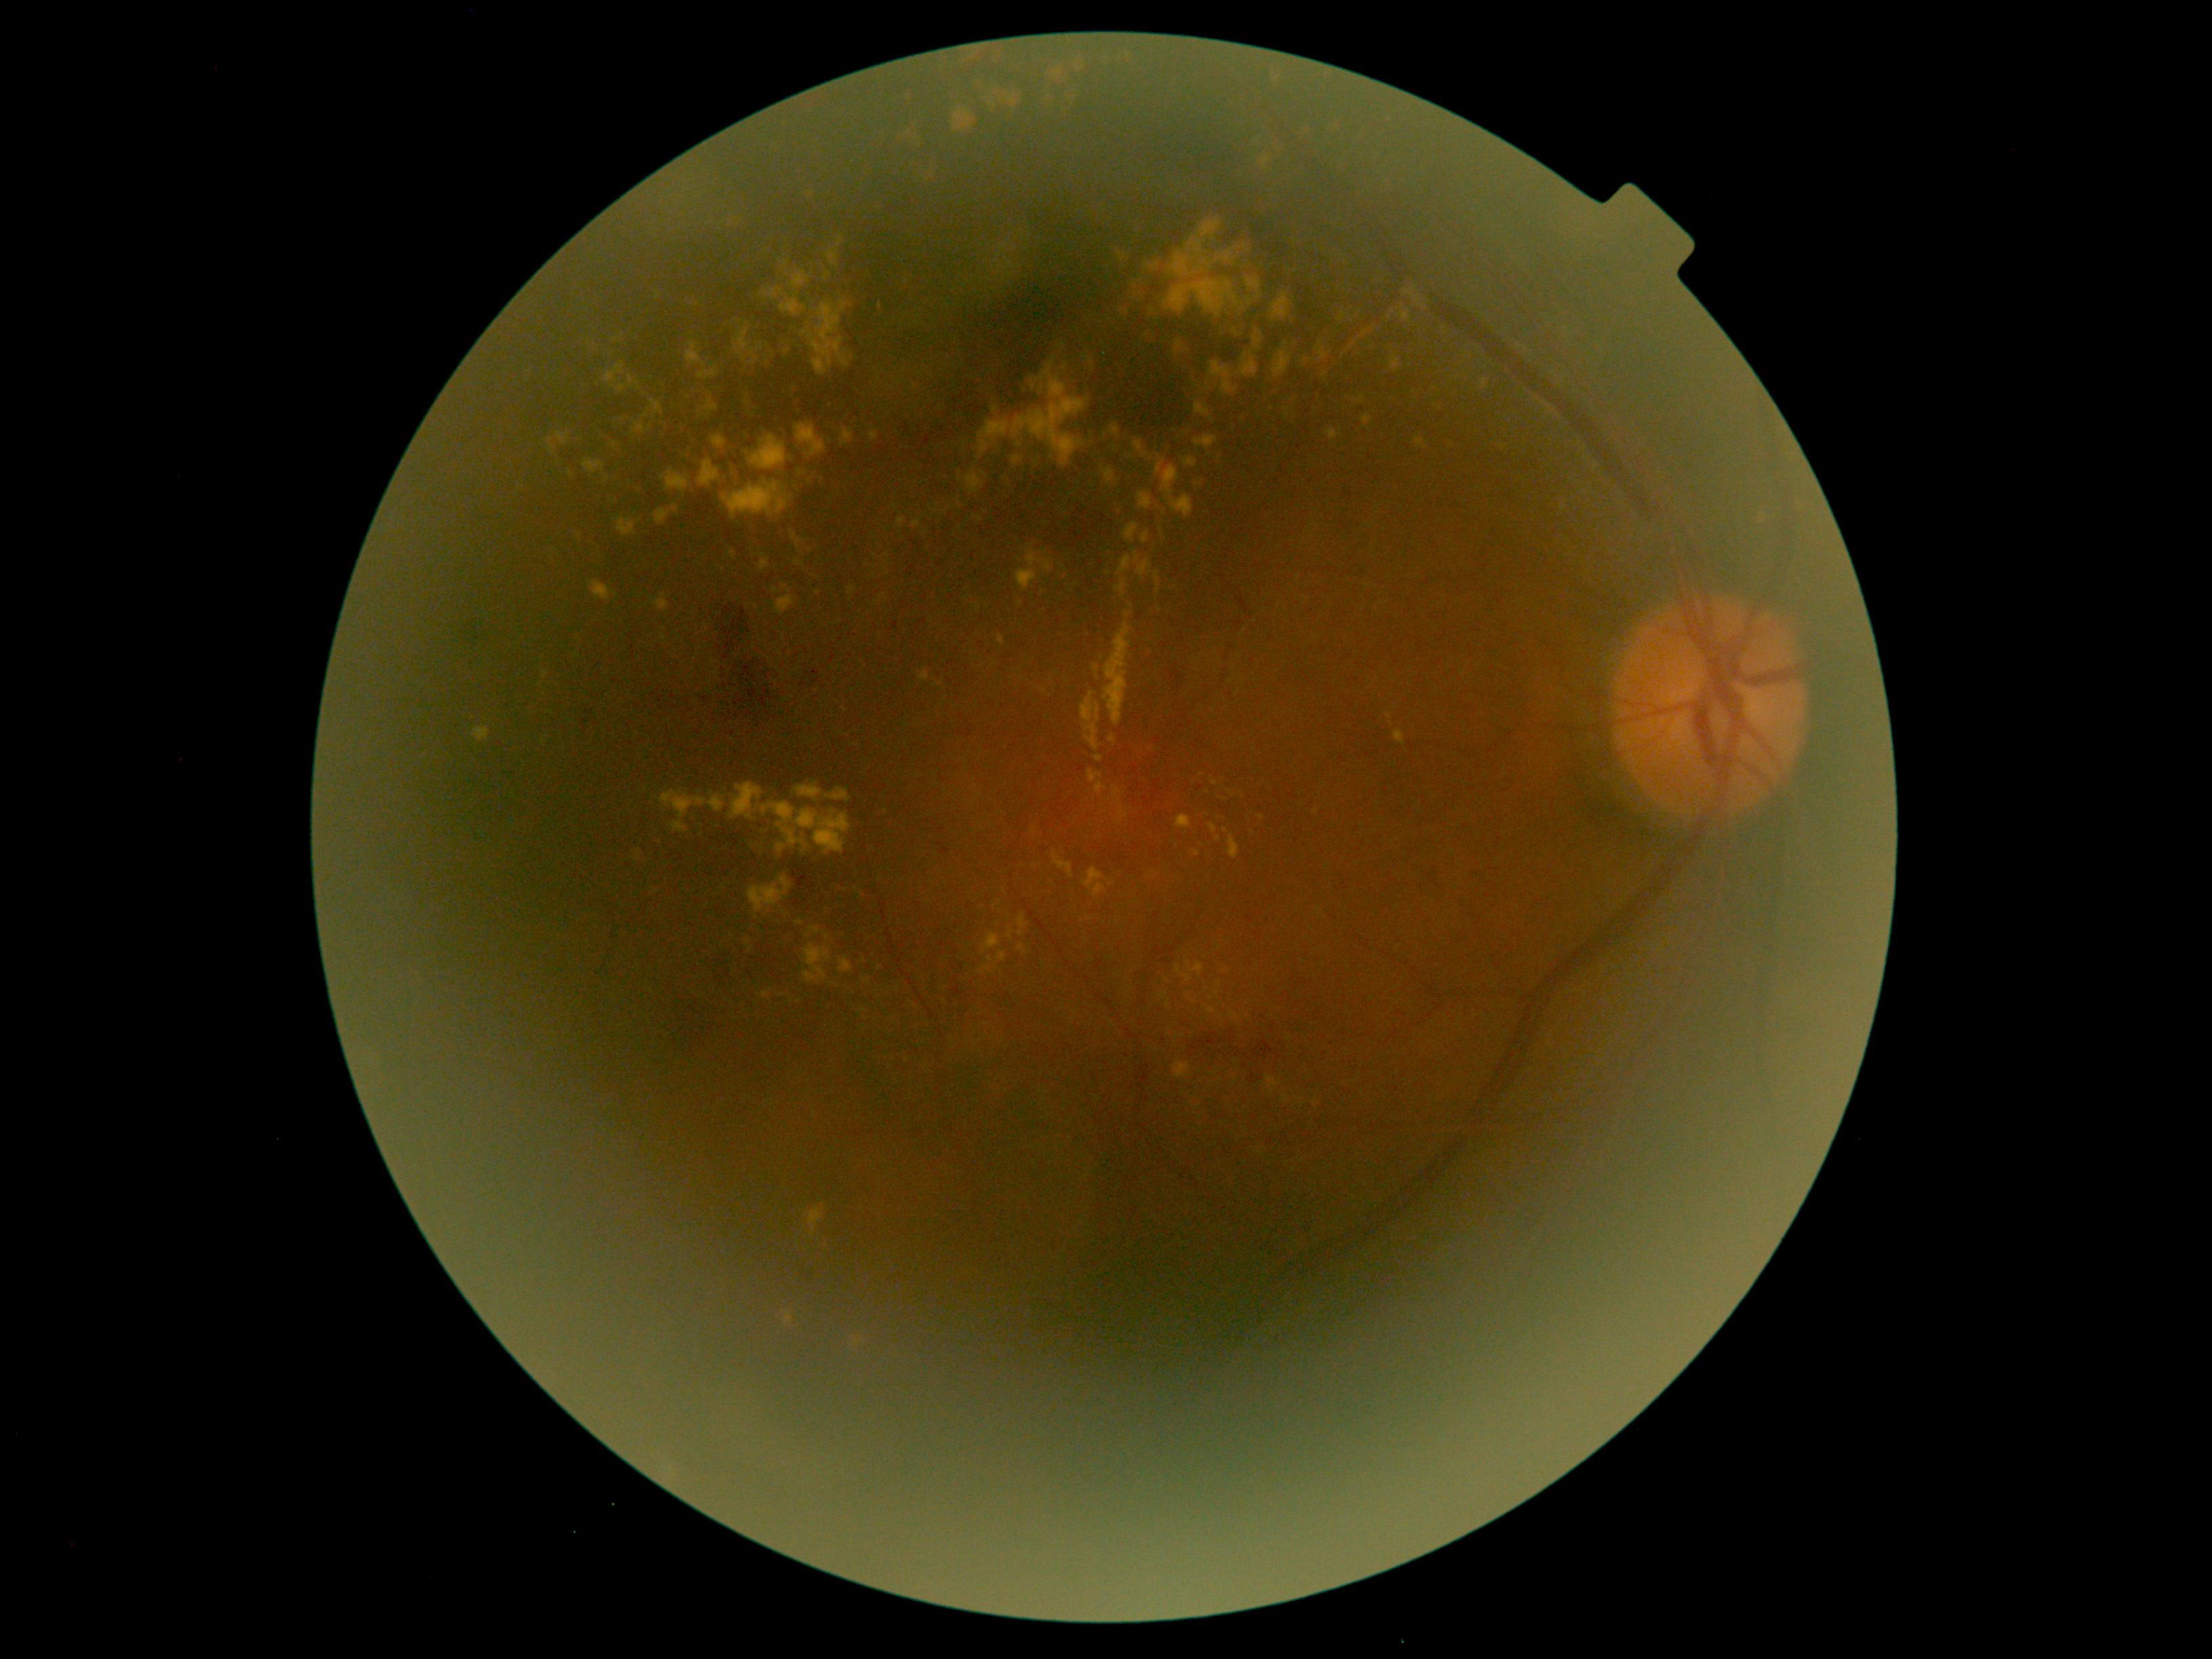
Diabetic retinopathy (DR): grade 2 (moderate NPDR)
Representative lesions:
hard exudates (EXs) (continued): {"left": 827, "top": 235, "right": 842, "bottom": 266}, {"left": 1113, "top": 787, "right": 1124, "bottom": 798}, {"left": 1109, "top": 425, "right": 1120, "bottom": 438}, {"left": 1248, "top": 298, "right": 1253, "bottom": 306}, {"left": 1017, "top": 550, "right": 1054, "bottom": 593}, {"left": 1204, "top": 1006, "right": 1215, "bottom": 1013}, {"left": 859, "top": 45, "right": 1138, "bottom": 213}, {"left": 1245, "top": 277, "right": 1261, "bottom": 293}, {"left": 1329, "top": 120, "right": 1347, "bottom": 140}, {"left": 699, "top": 459, "right": 720, "bottom": 487}, {"left": 1267, "top": 1076, "right": 1277, "bottom": 1094}, {"left": 1126, "top": 612, "right": 1134, "bottom": 619}, {"left": 1085, "top": 357, "right": 1094, "bottom": 367}
Smaller EXs around (x=782, y=995), (x=835, y=984), (x=999, y=904), (x=1152, y=309), (x=883, y=596), (x=937, y=685), (x=1164, y=511)
hemorrhages (HEs) (continued): {"left": 1343, "top": 489, "right": 1353, "bottom": 502}, {"left": 705, "top": 954, "right": 747, "bottom": 996}, {"left": 1253, "top": 1038, "right": 1282, "bottom": 1061}, {"left": 692, "top": 688, "right": 715, "bottom": 712}, {"left": 1188, "top": 1029, "right": 1237, "bottom": 1058}, {"left": 1202, "top": 1052, "right": 1210, "bottom": 1062}, {"left": 1248, "top": 1071, "right": 1265, "bottom": 1084}, {"left": 802, "top": 670, "right": 829, "bottom": 697}, {"left": 719, "top": 604, "right": 779, "bottom": 724}, {"left": 914, "top": 1130, "right": 924, "bottom": 1139}, {"left": 853, "top": 250, "right": 1115, "bottom": 463}
microaneurysms (MAs): none detected
soft exudates (SEs): none detected